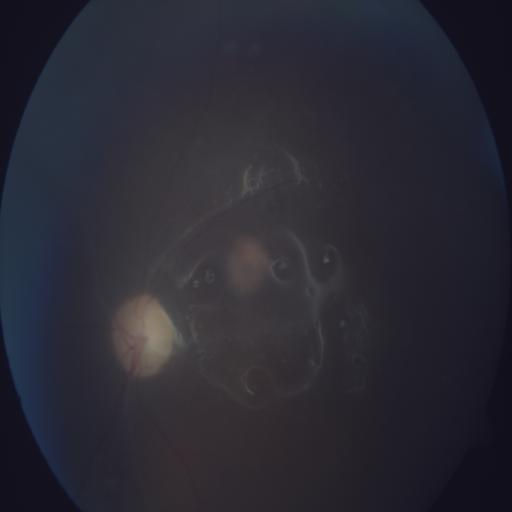
Color fundus photograph showing optic disc pallor.